Camera: Remidio Fundus on Phone (FOP) camera. Image size 1659x2212 — 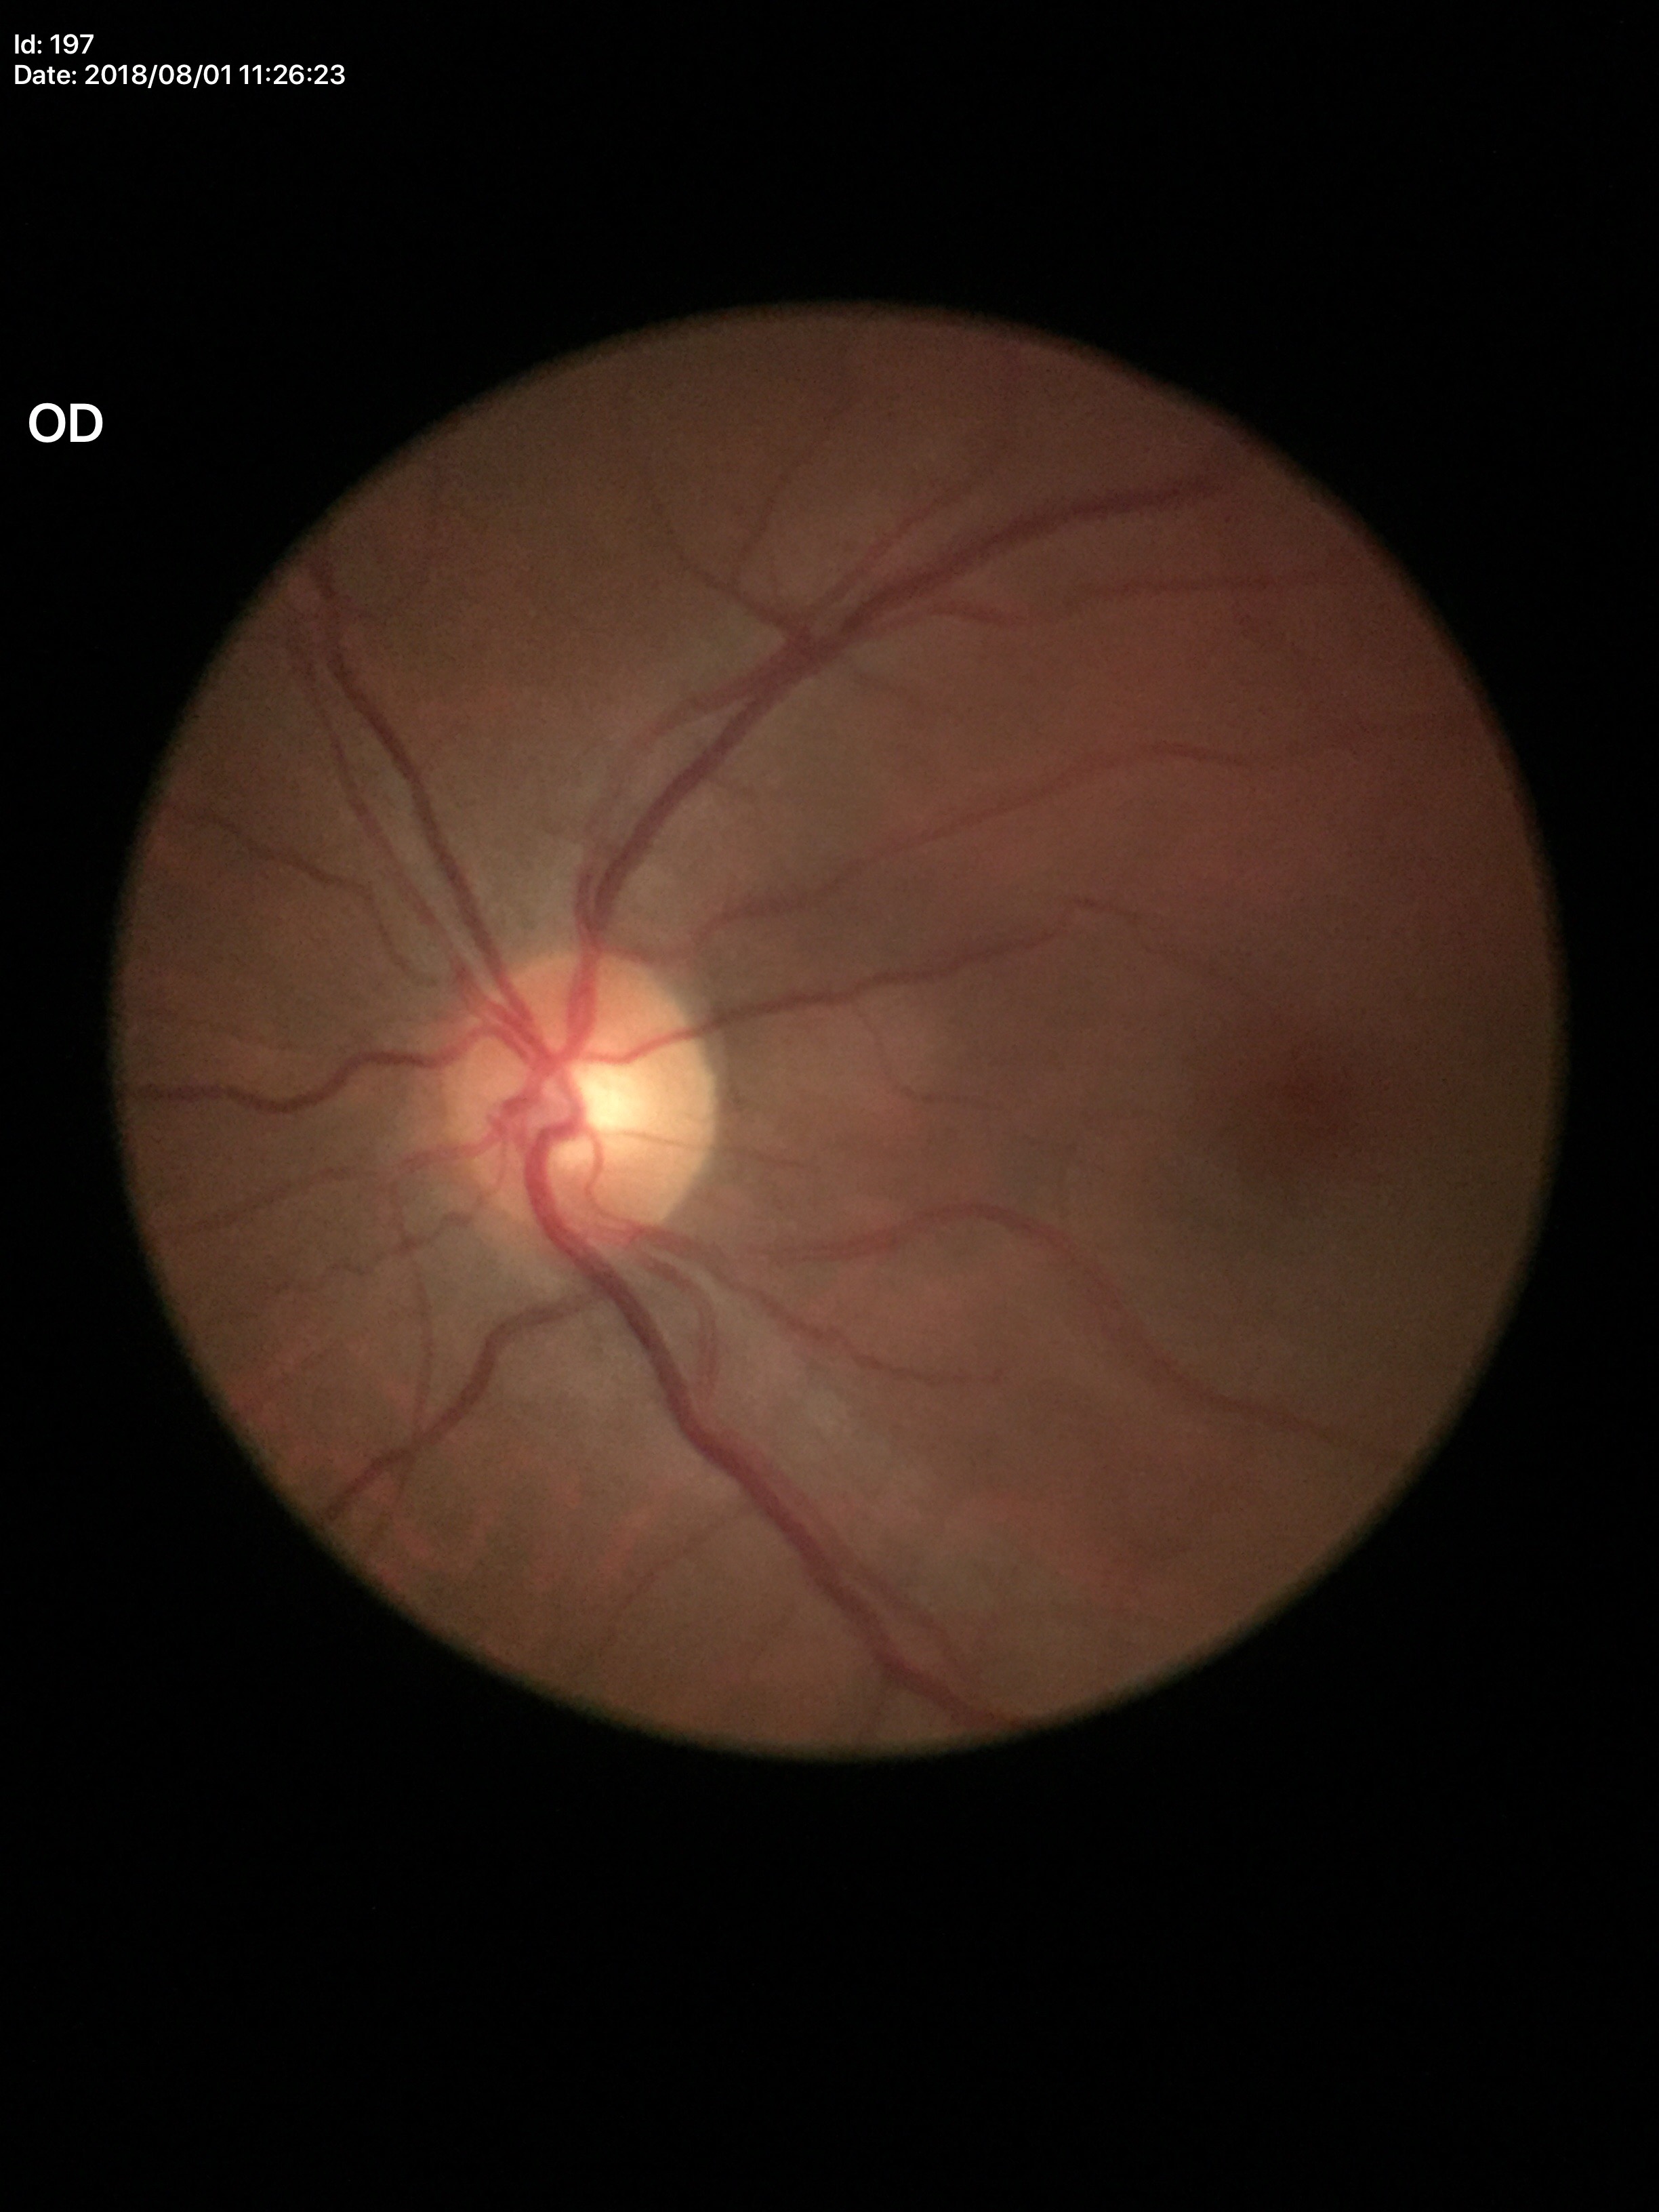

No glaucomatous optic neuropathy (5/5 ophthalmologists in agreement). Vertical C/D ratio (VCDR) of 0.51.